1624x1232px: 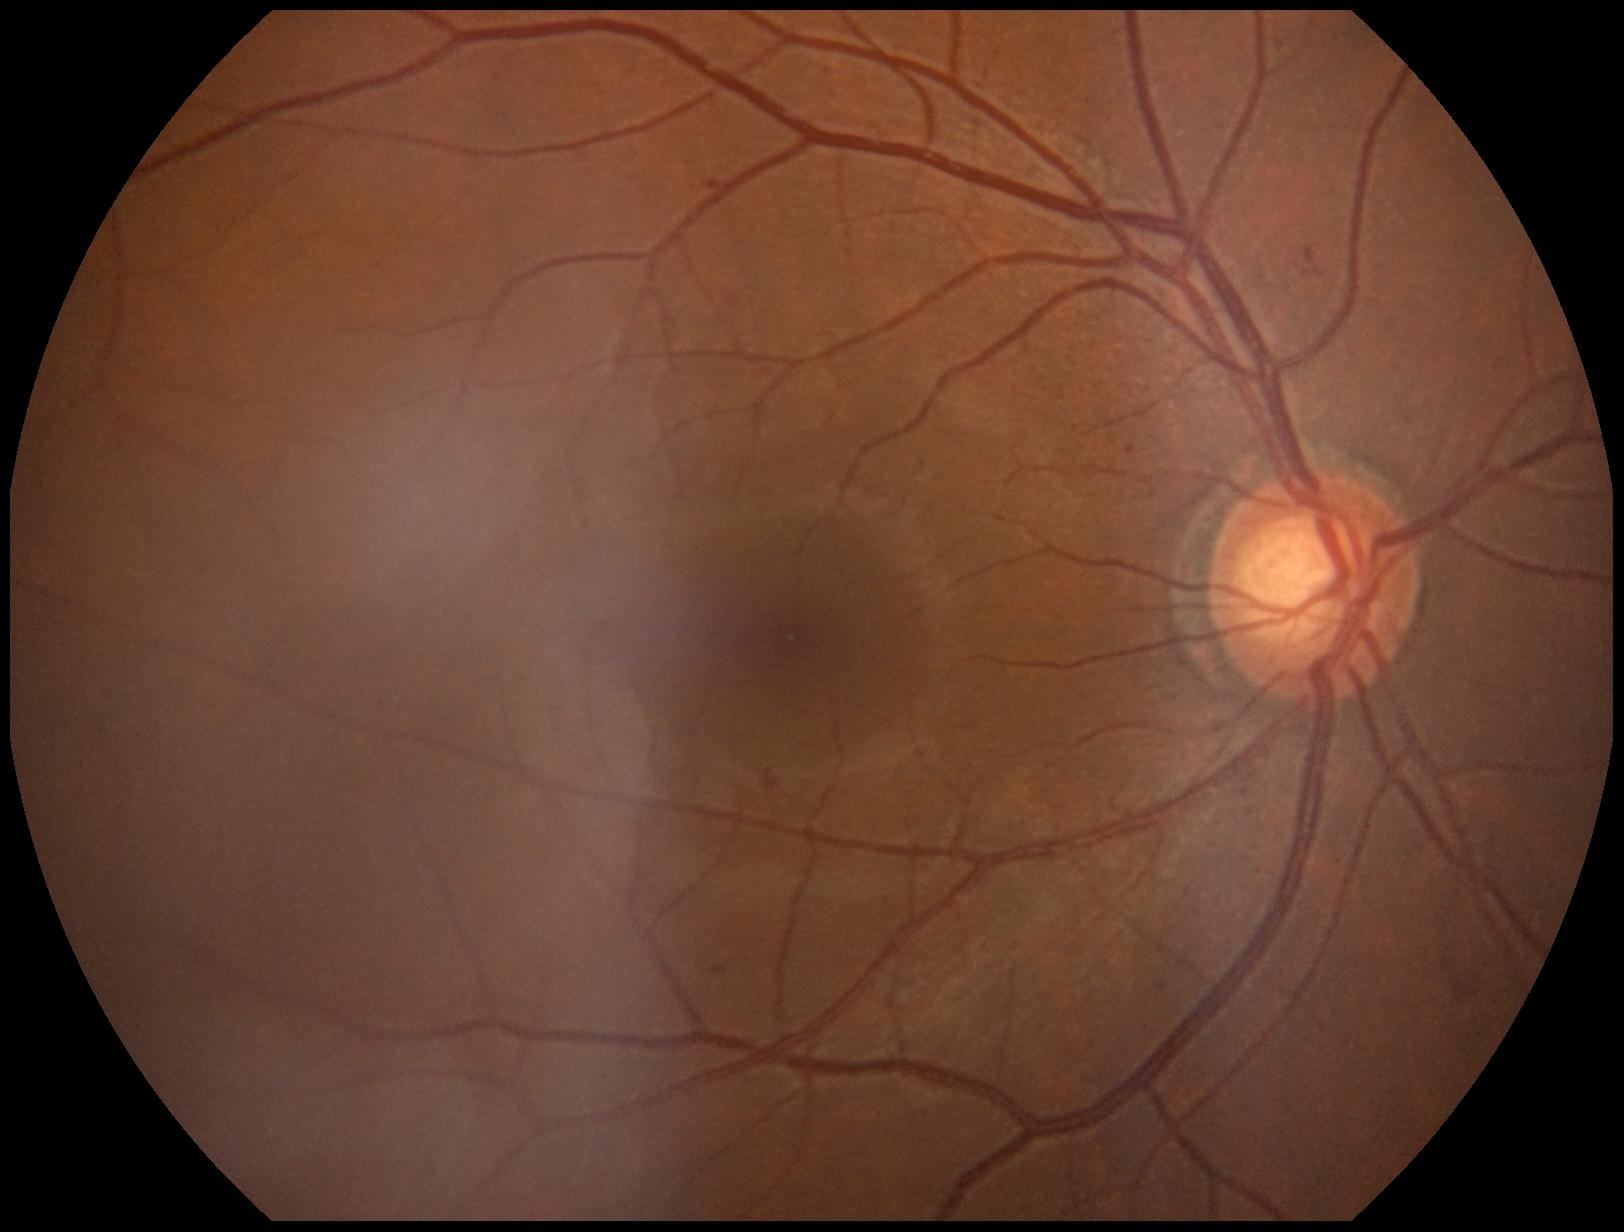

DR: 2.